512x512px: 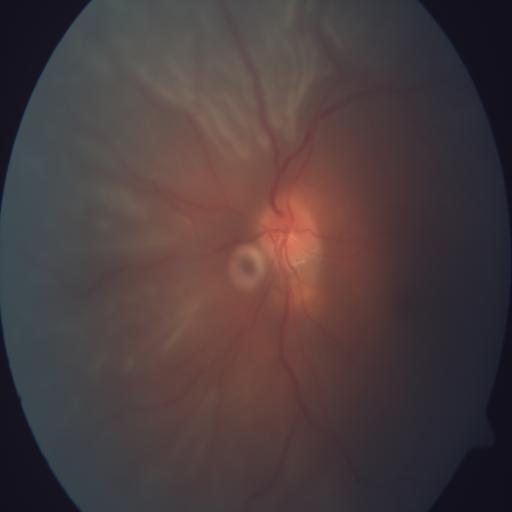

The image shows RD (retinal detachment).